1960x1897 — 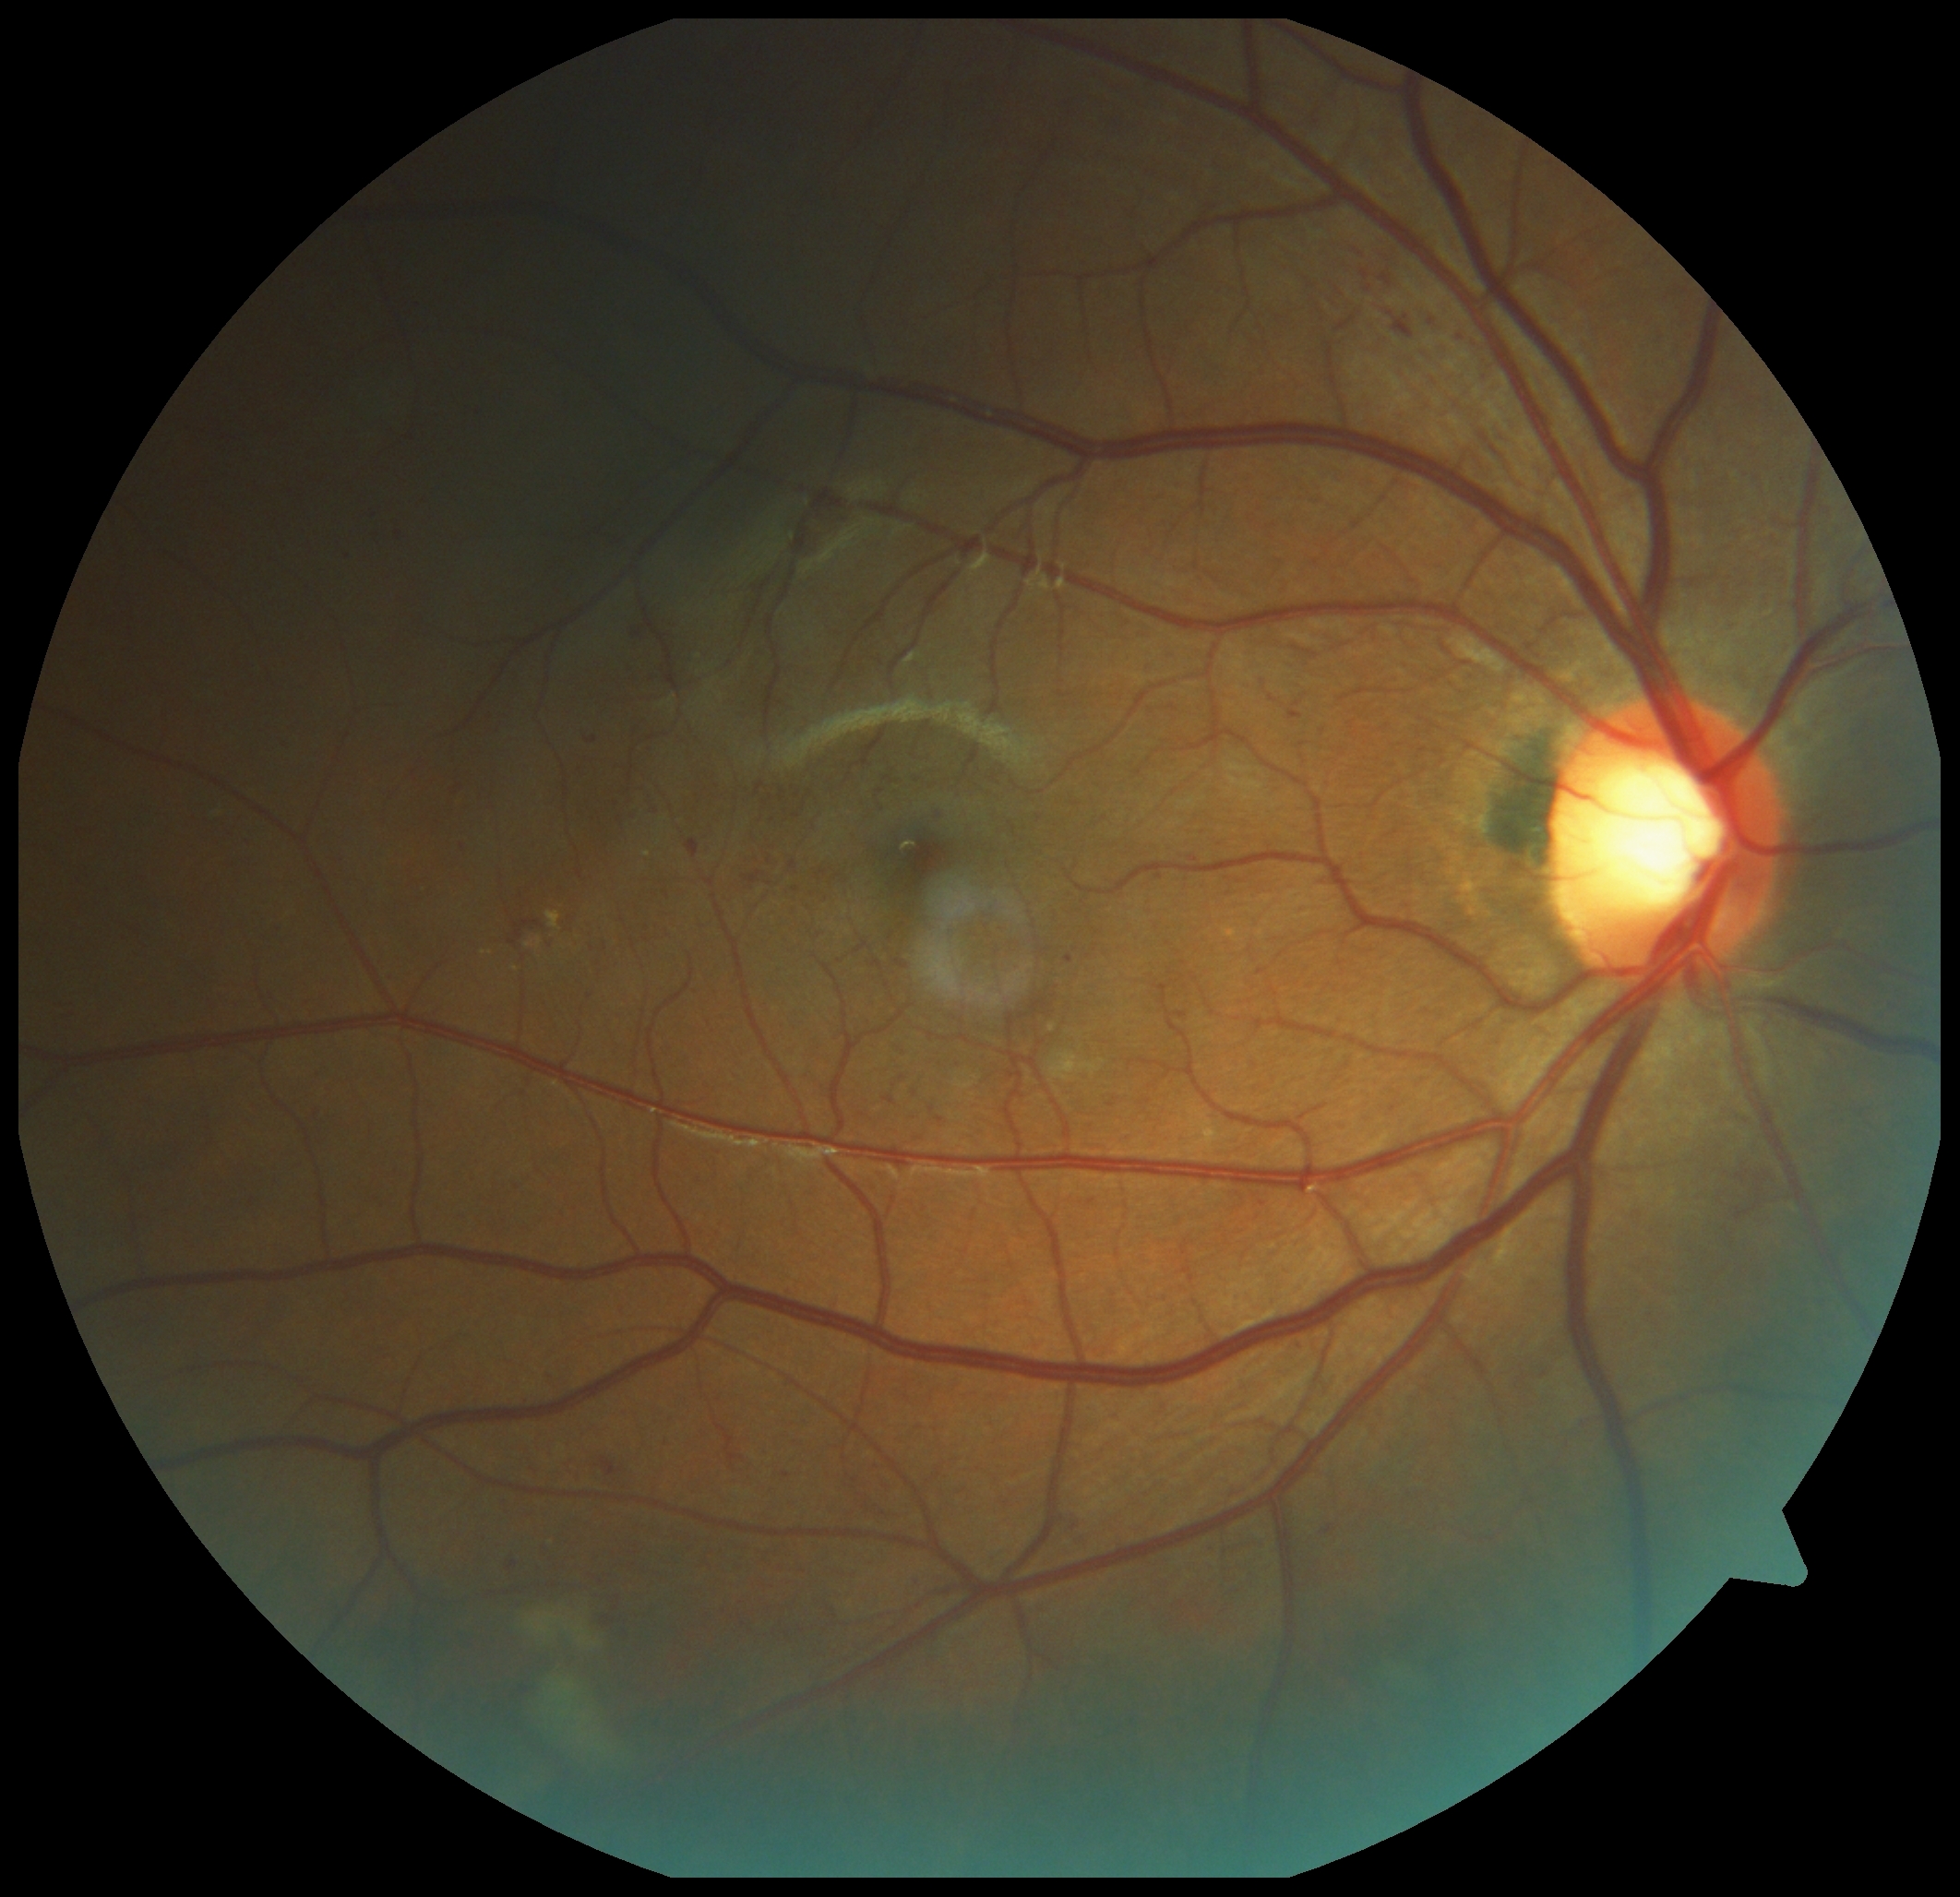 Diabetic retinopathy (DR): grade 2 (moderate NPDR); non-proliferative diabetic retinopathy.
Microaneurysms (MAs) include bbox(1454, 330, 1462, 343) | bbox(1065, 956, 1074, 963) | bbox(632, 631, 642, 638) | bbox(588, 738, 599, 744) | bbox(687, 840, 700, 858) | bbox(783, 1473, 791, 1479) | bbox(1381, 275, 1392, 287) | bbox(454, 843, 463, 853) | bbox(367, 514, 373, 524) | bbox(1176, 1005, 1186, 1018) | bbox(929, 805, 939, 817).
Smaller MAs around <pt>1331,1530</pt> | <pt>399,534</pt> | <pt>1432,323</pt> | <pt>617,1608</pt>.